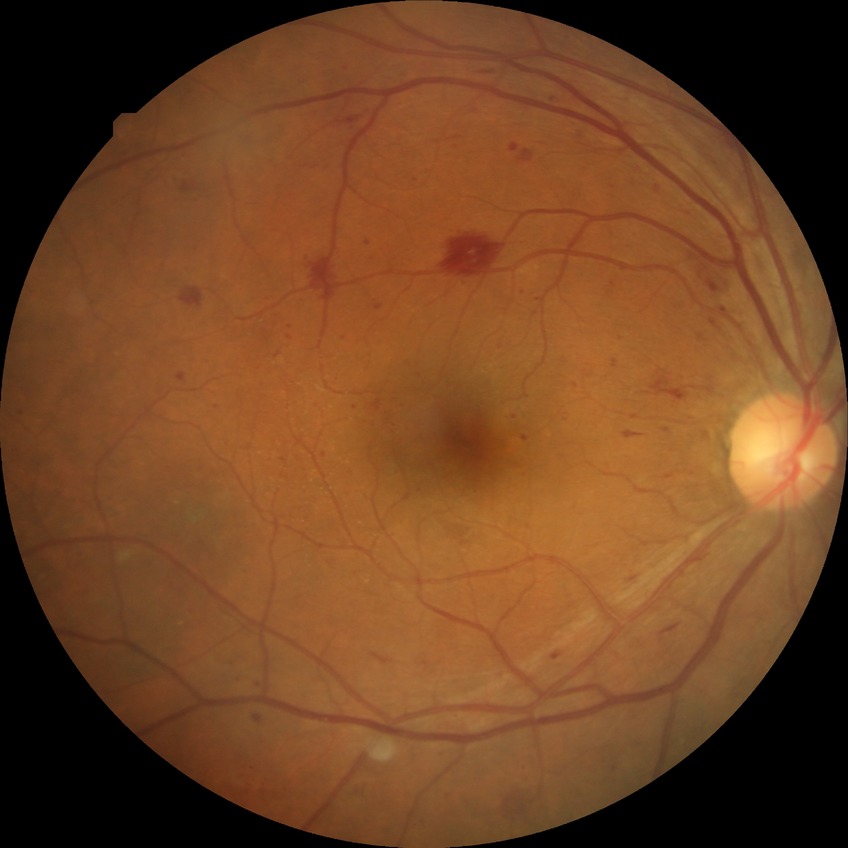

DR grade is PPDR. Disease class: non-proliferative diabetic retinopathy.